Diabetic retinopathy graded by the modified Davis classification.
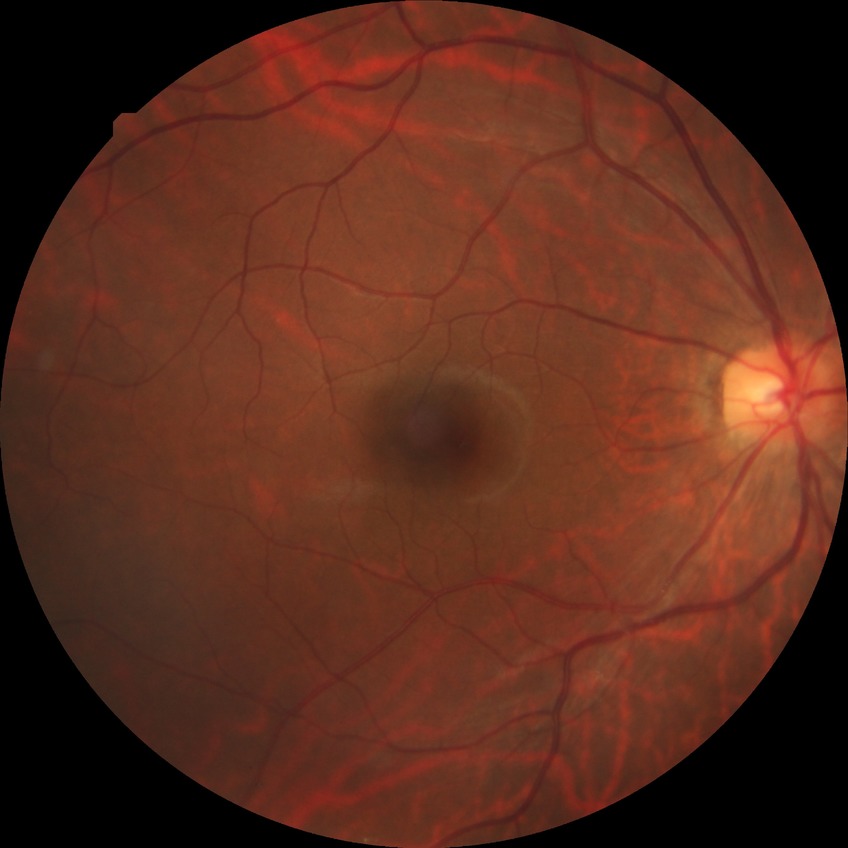
retinopathy stage@no diabetic retinopathy.